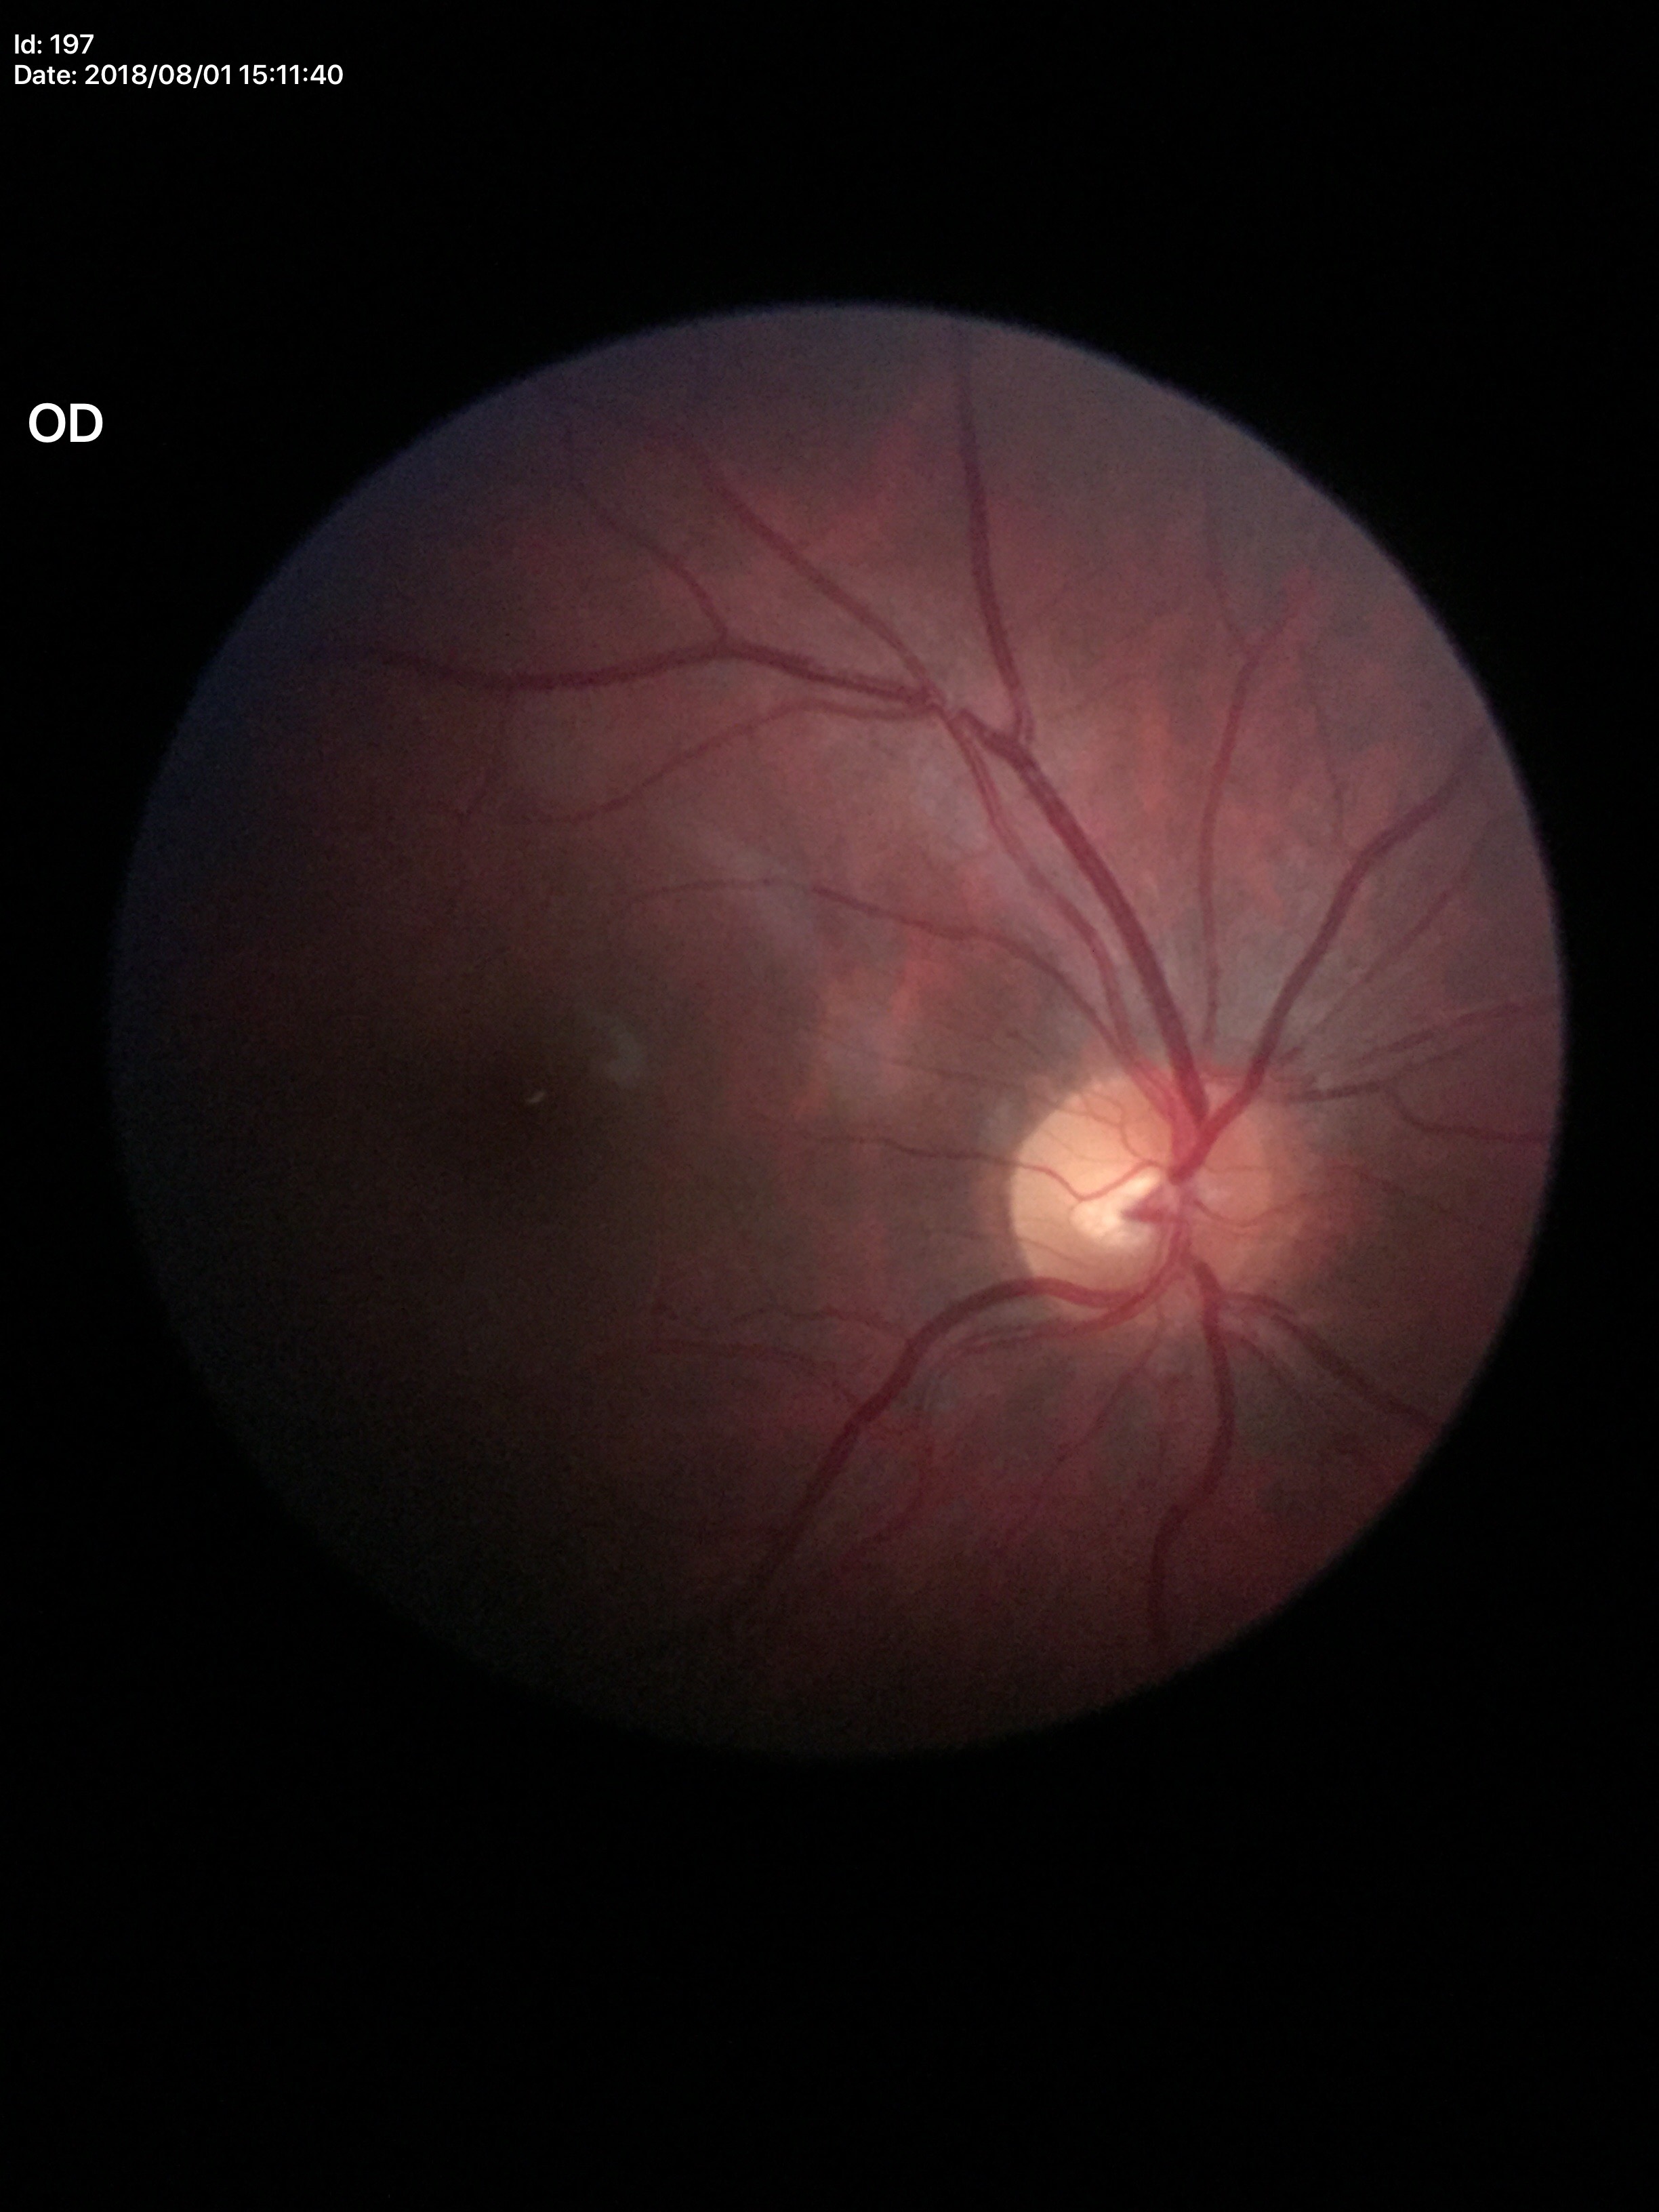 Glaucoma assessment: no suspicious findings (unanimous normal call). Vertical cup-disc ratio is 0.48. Horizontal cup-disc ratio: 0.53.